Retinal fundus photograph, nonmydriatic fundus photograph — 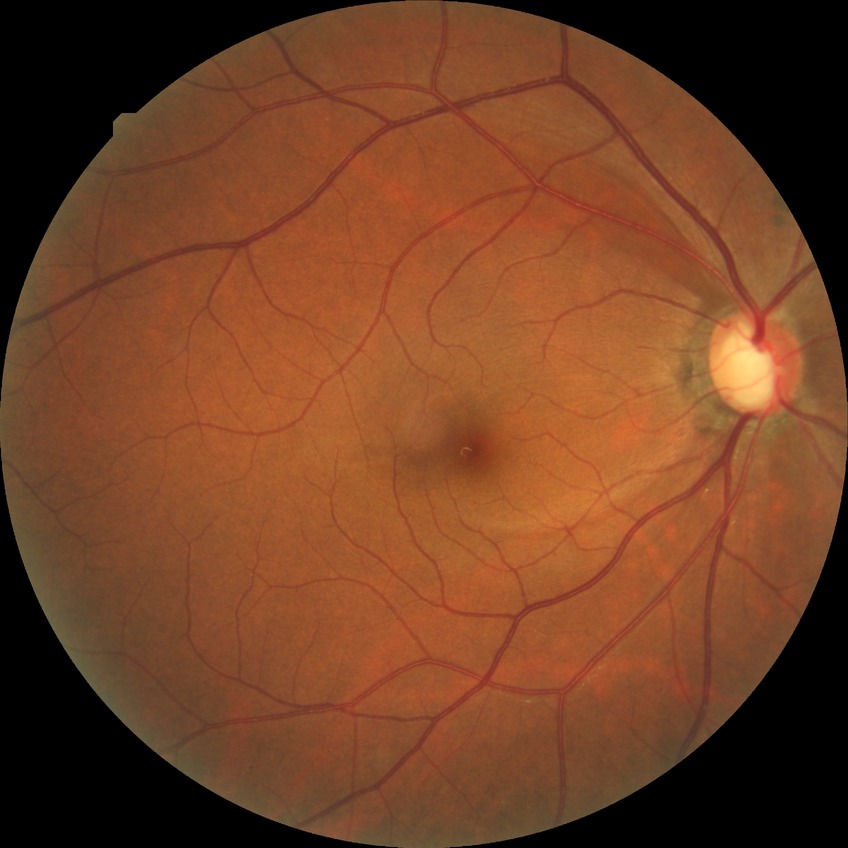

Retinopathy stage is no diabetic retinopathy.